2352x1568px, retinal fundus photograph
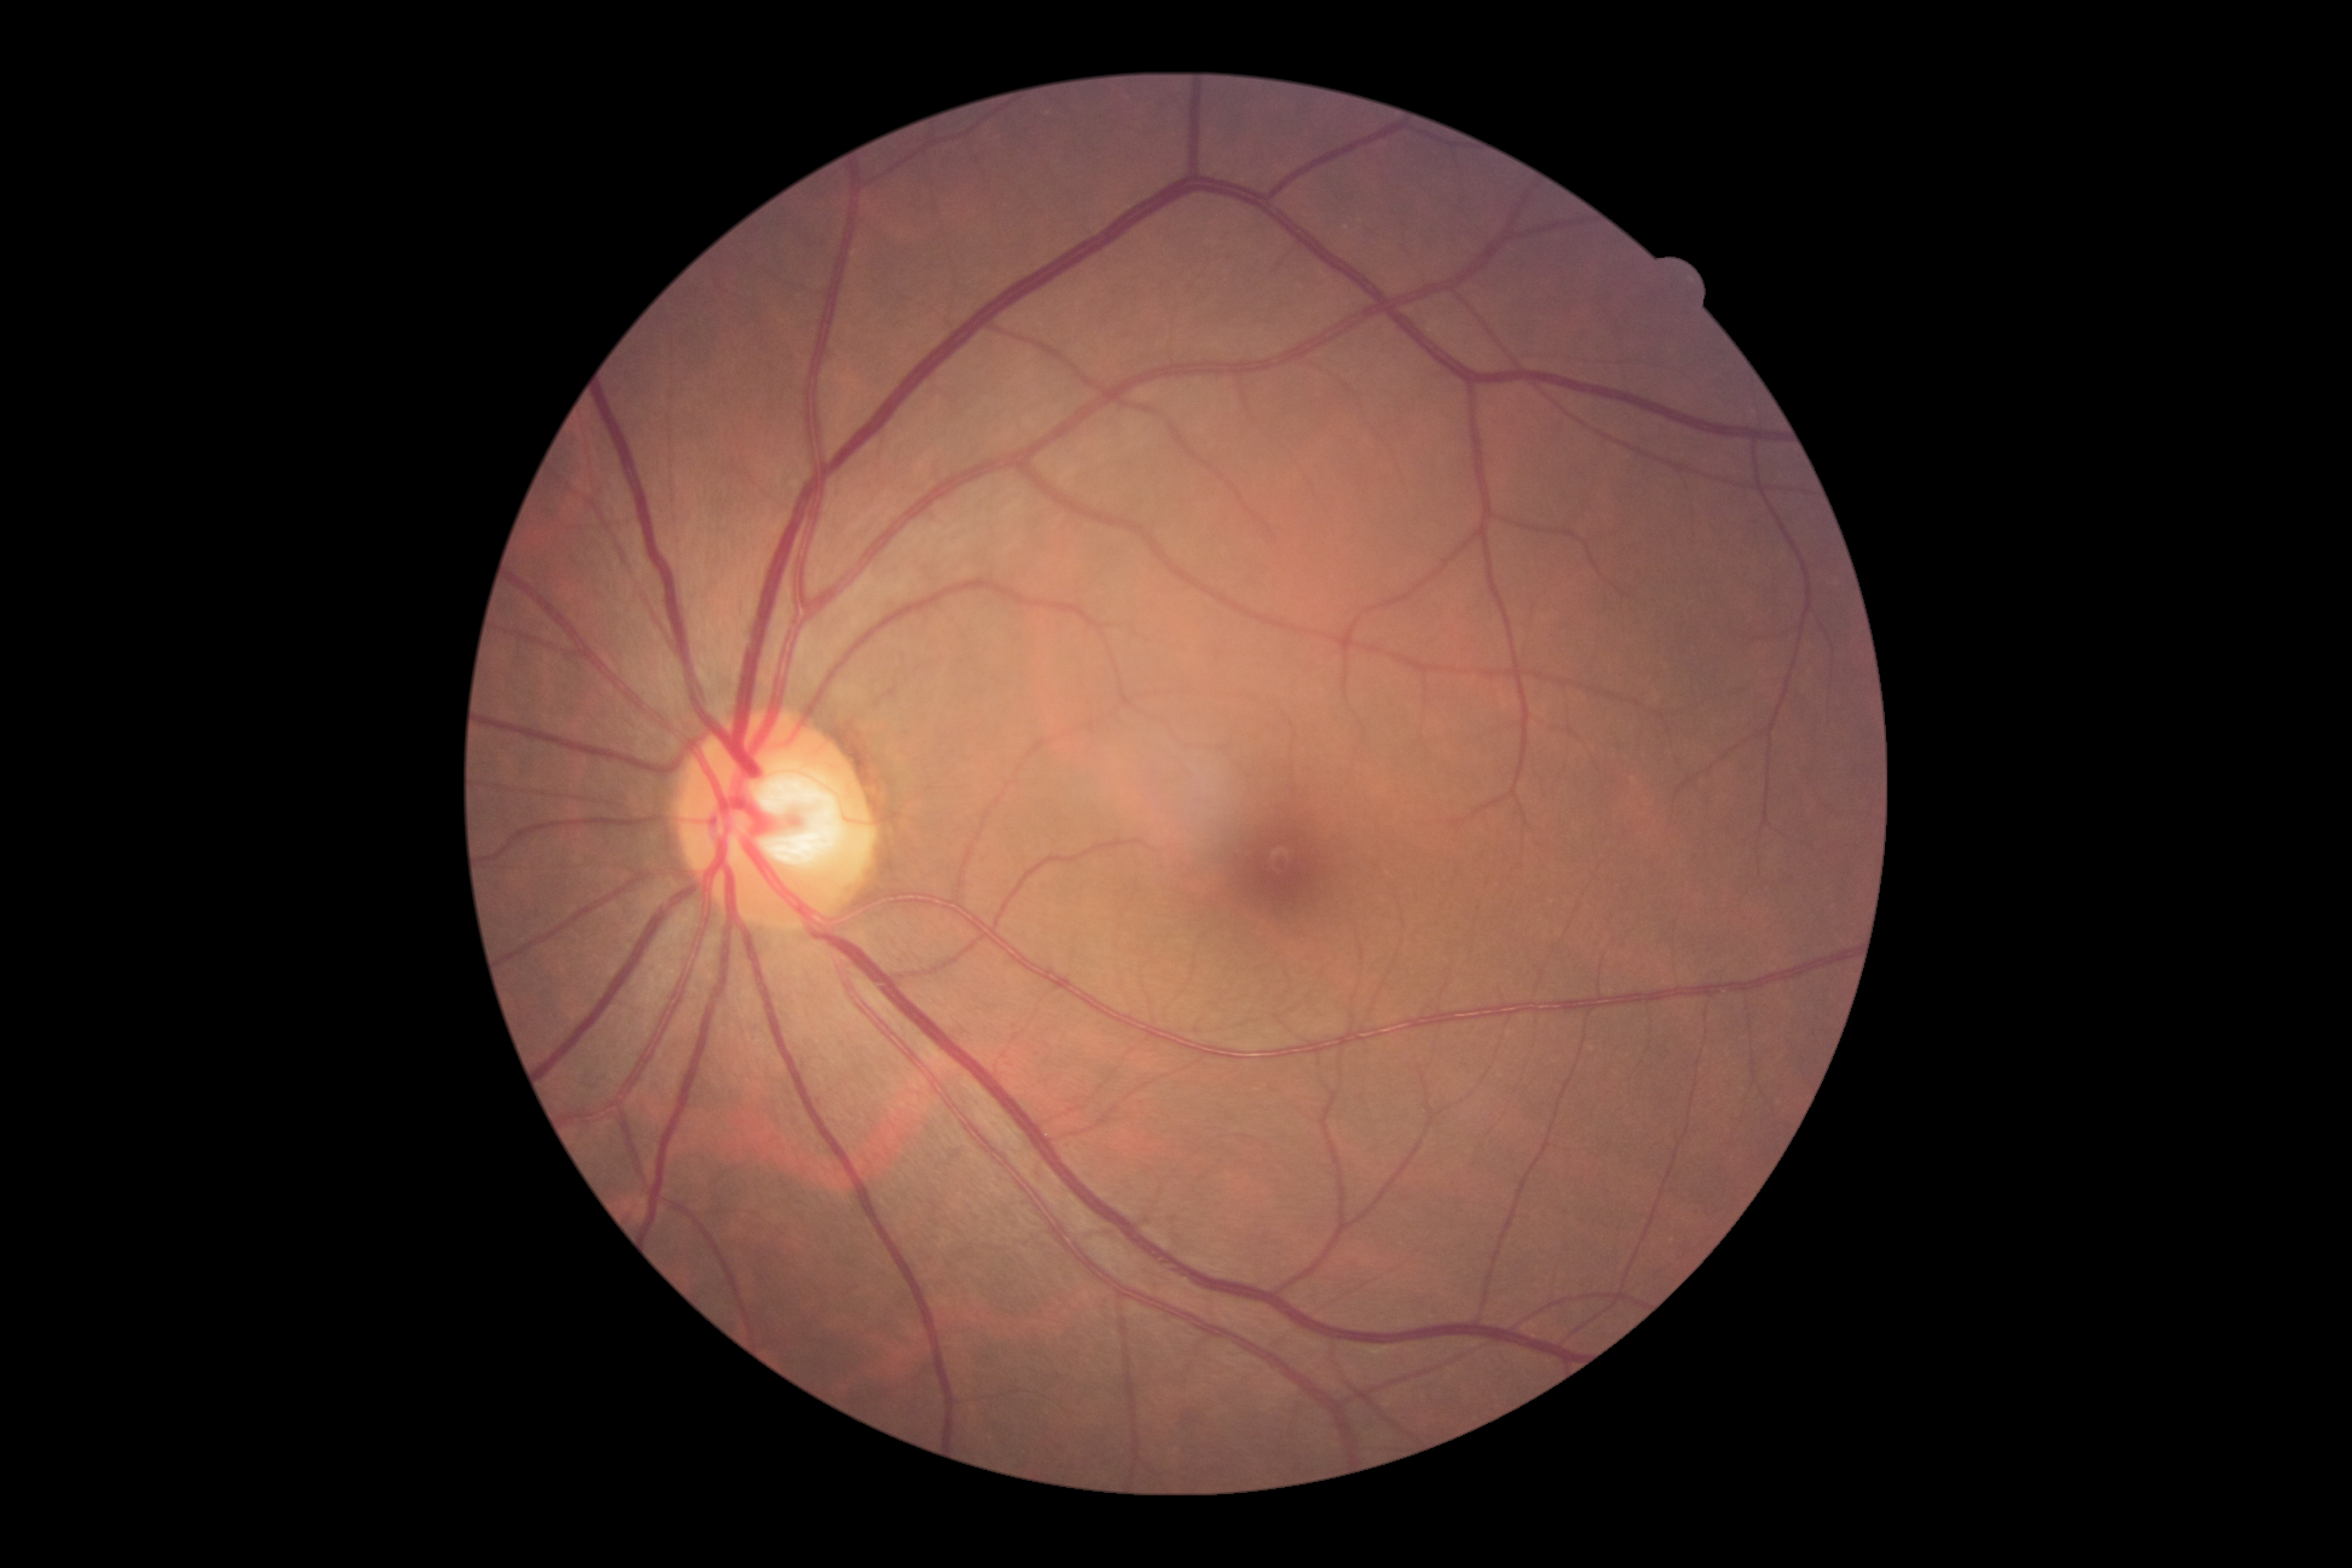
Diabetic retinopathy grade is 0. No signs of diabetic retinopathy.